FOV: 45 degrees. Color fundus image
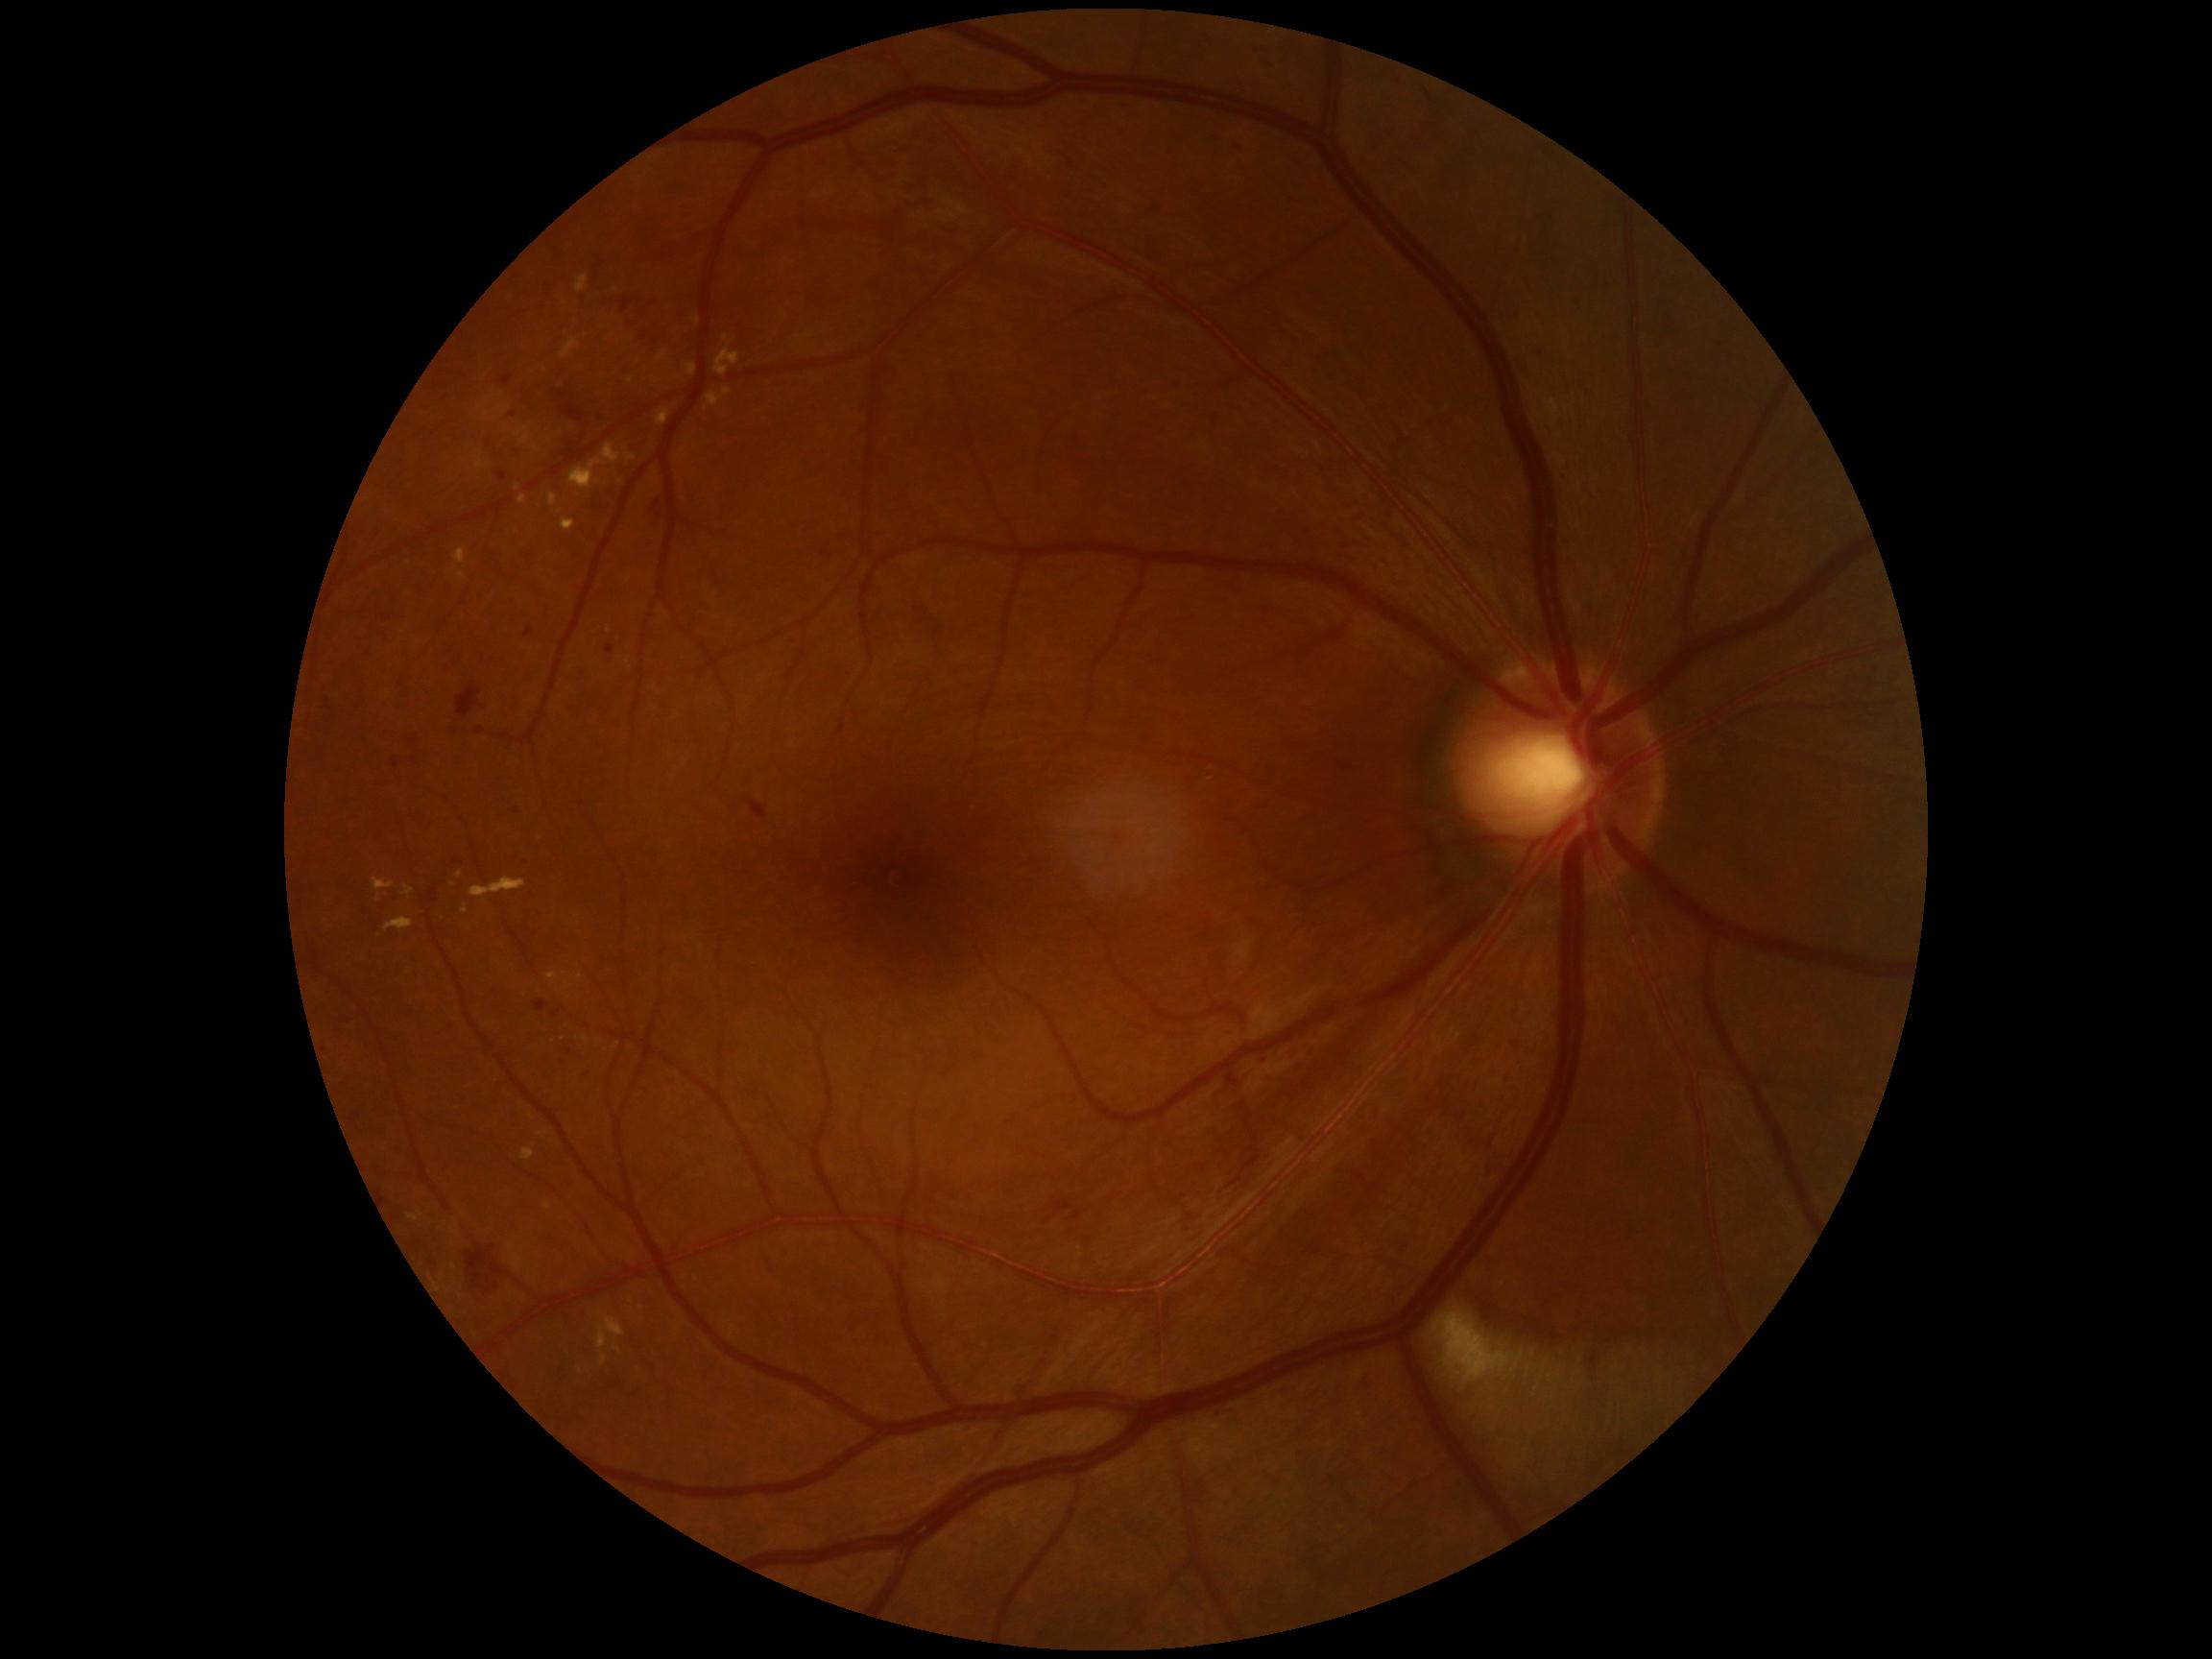 <lesions partial="true">
  <dr_grade>2</dr_grade>
  <ex partial="true"><bbox>582, 1037, 590, 1043</bbox>; <bbox>560, 340, 581, 359</bbox>; <bbox>595, 1317, 626, 1350</bbox>; <bbox>521, 1149, 534, 1160</bbox>; <bbox>404, 885, 415, 897</bbox>; <bbox>576, 276, 589, 295</bbox>; <bbox>548, 974, 558, 980</bbox>; <bbox>462, 906, 469, 915</bbox>; <bbox>600, 1356, 608, 1366</bbox>; <bbox>562, 517, 576, 531</bbox></ex>
  <ex_small_centers>(540, 839); (580, 976); (726, 338); (560, 513); (438, 1290); (548, 1207)</ex_small_centers>
</lesions>